2361x1568px — 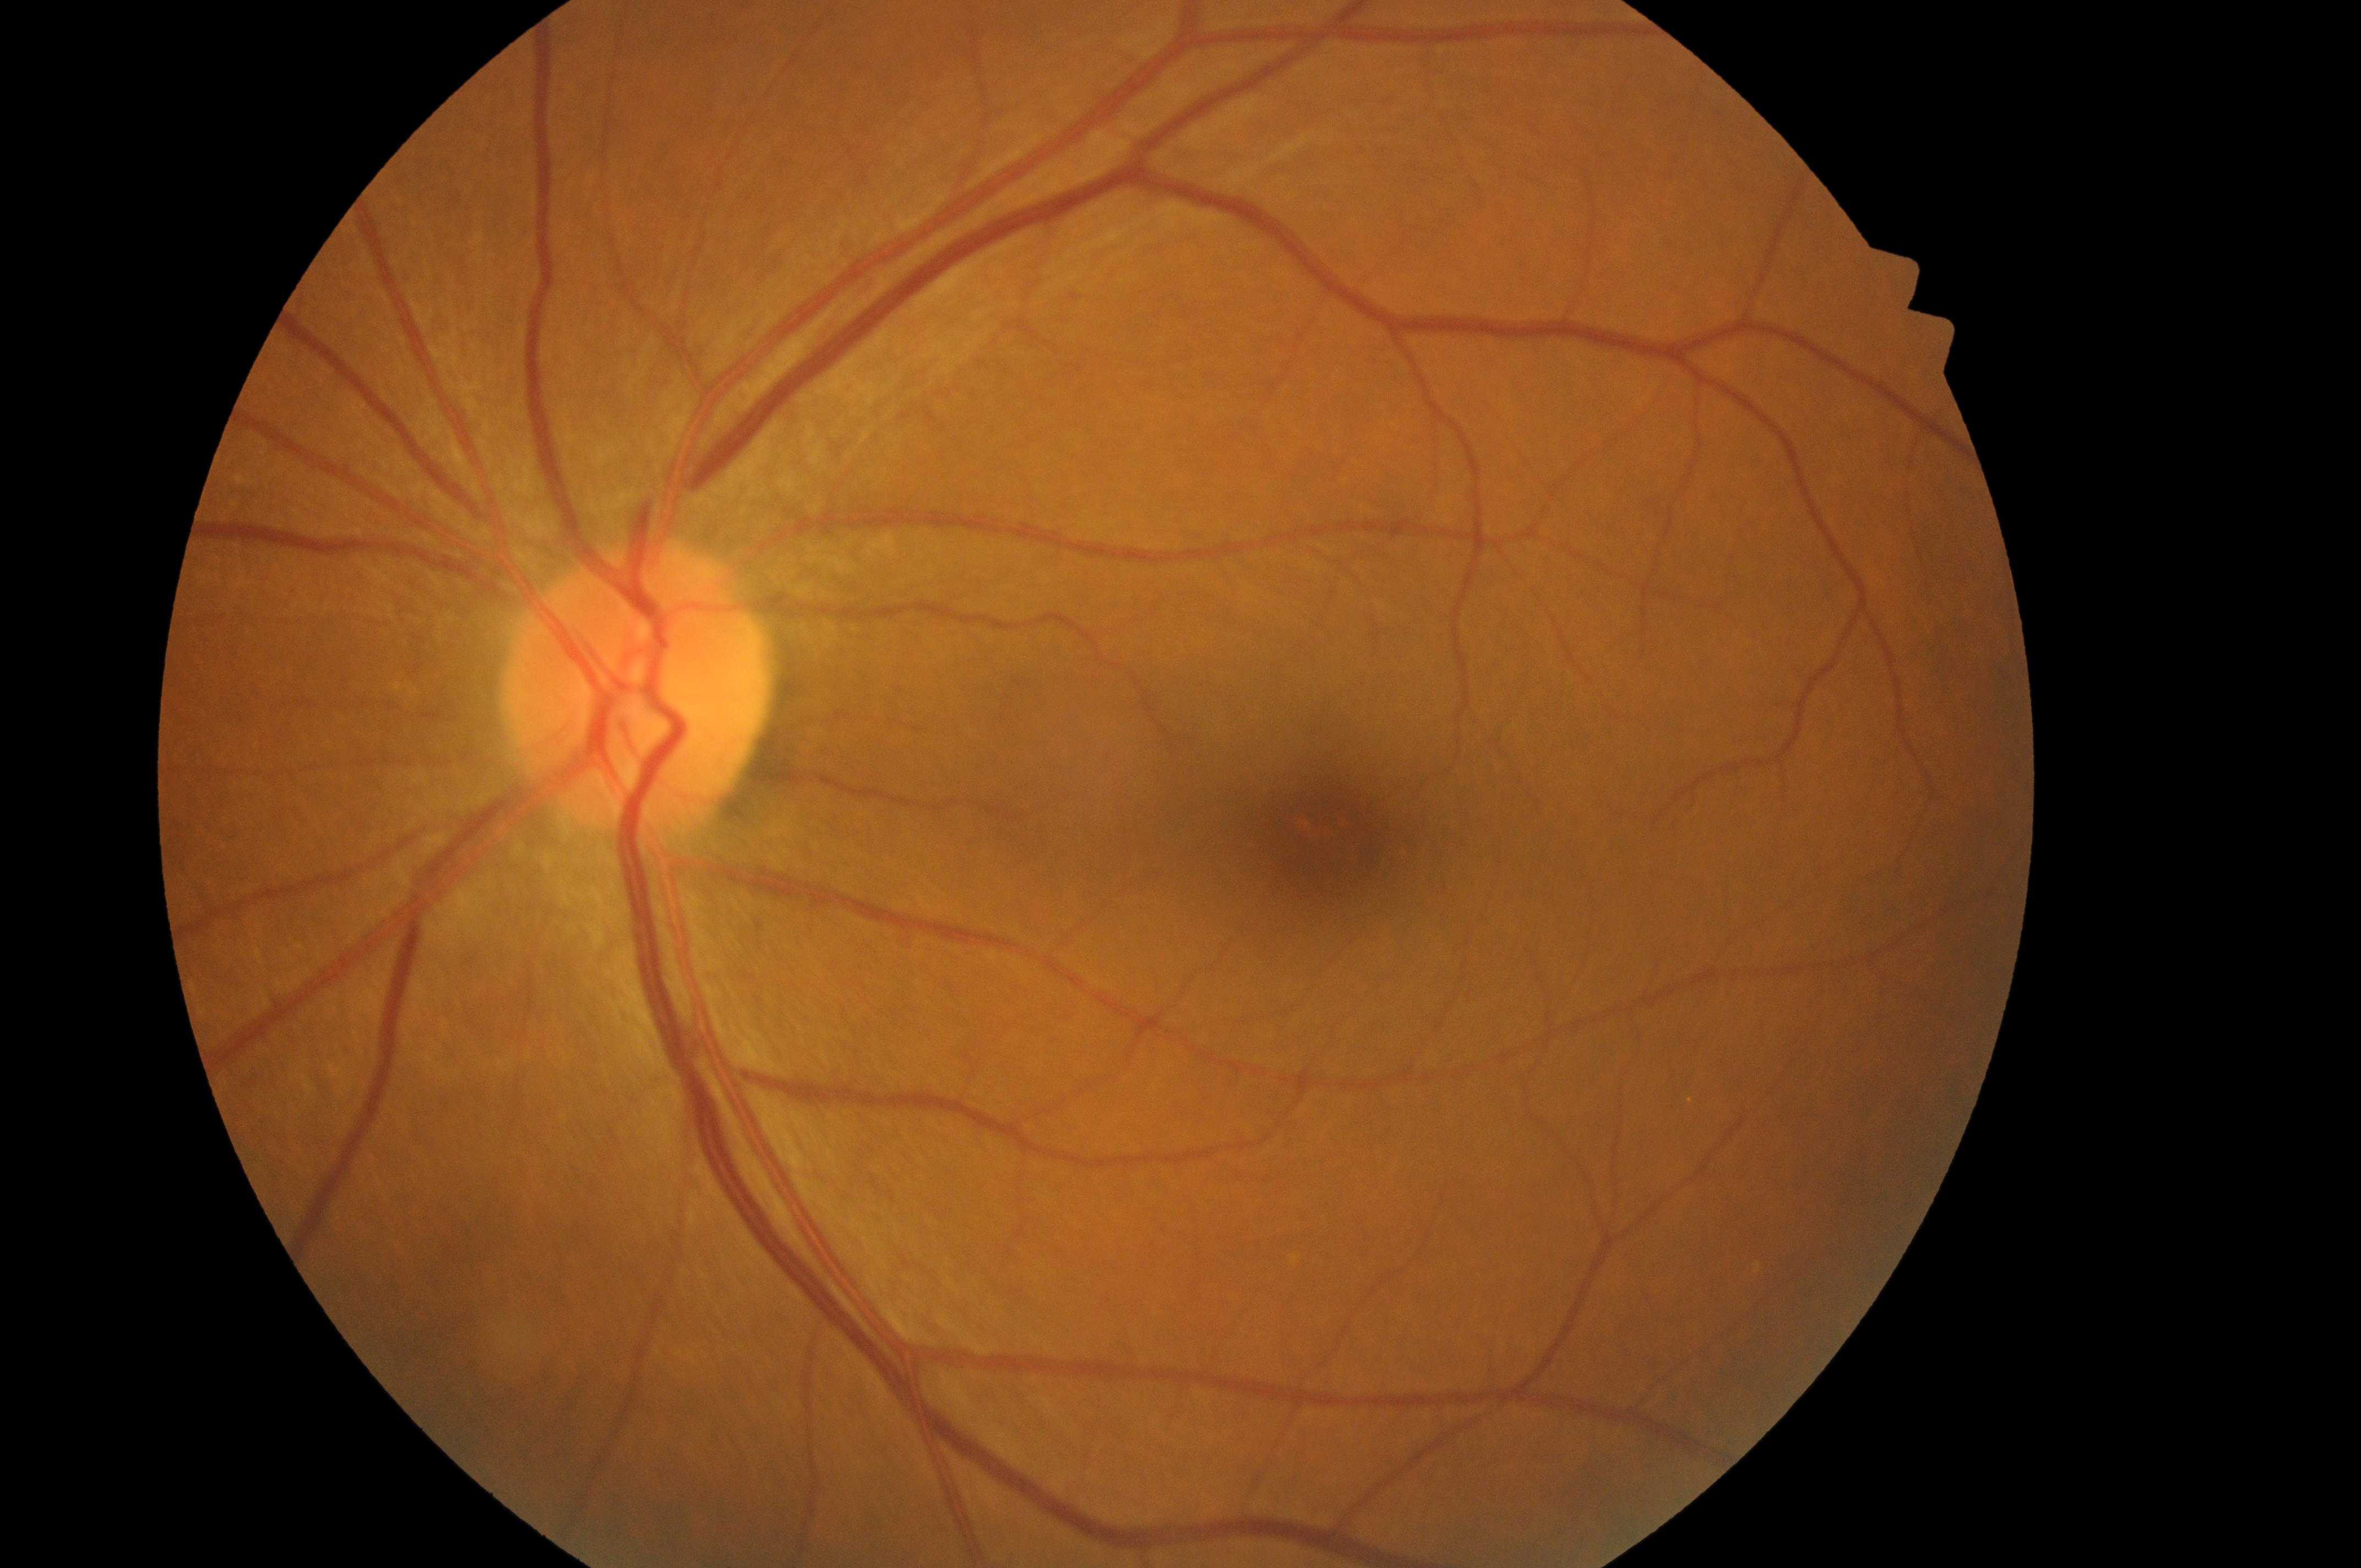

eye: left eye
dr_grade: 0 (no apparent retinopathy)
fovea: (x=1326, y=837)
optic_disc: (x=627, y=703)
dme_grade: no risk (grade 0)